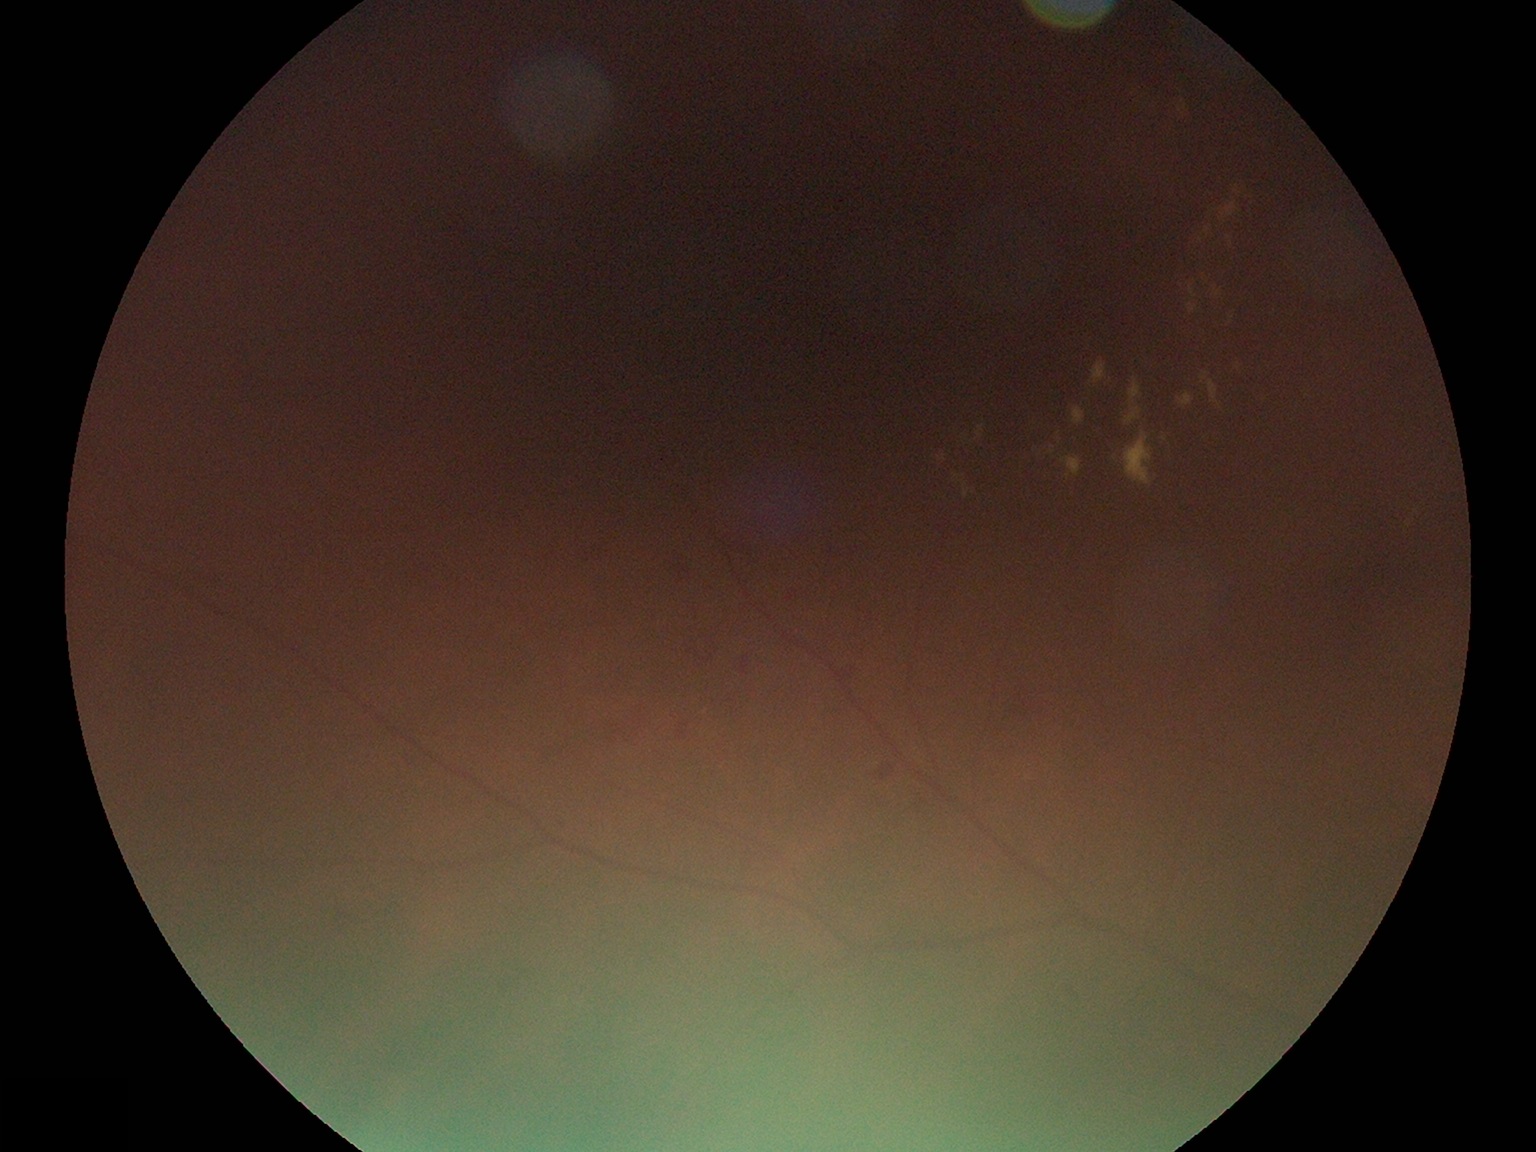

{"dr_grade": "moderate non-proliferative diabetic retinopathy (grade 2)", "dr_category": "non-proliferative diabetic retinopathy"}